45° FOV: 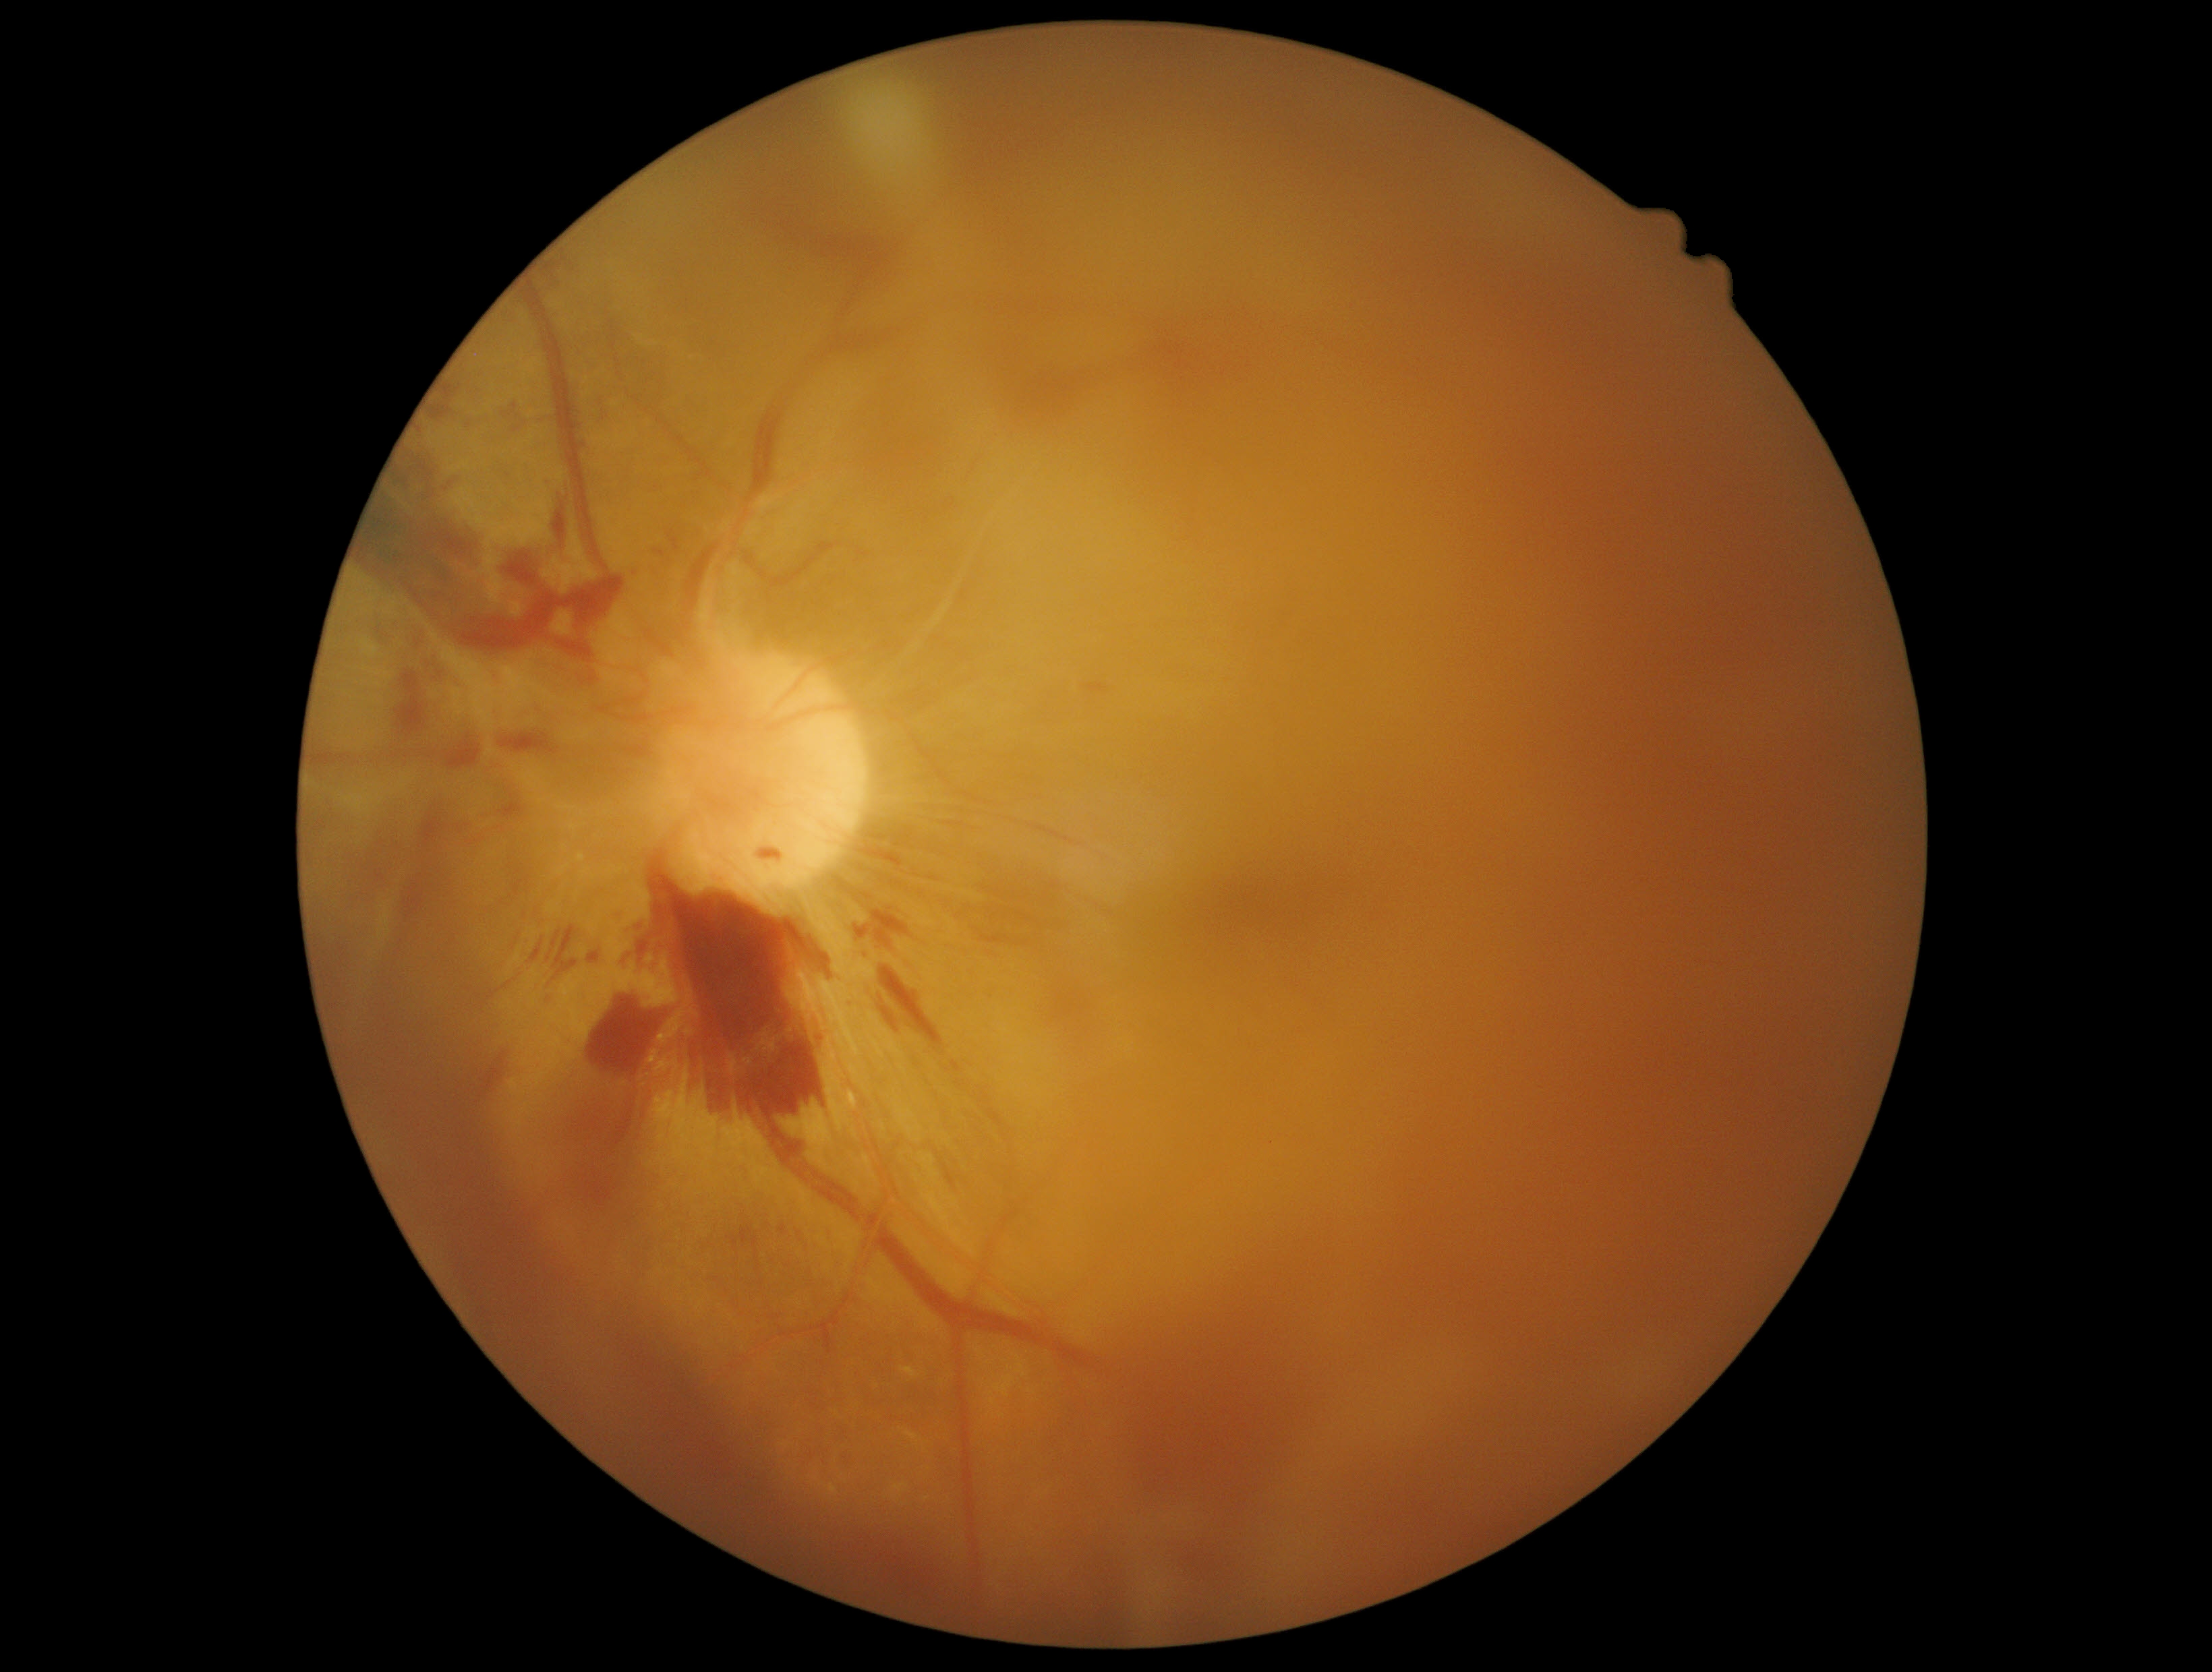
{"partial": true, "dr_grade": 4, "dr_grade_name": "PDR", "lesions": {"he": [[856, 822, 919, 873], [972, 874, 1066, 949], [377, 838, 385, 846], [933, 1148, 957, 1189], [1081, 678, 1111, 698], [465, 419, 473, 431], [640, 860, 834, 1136], [666, 529, 680, 555], [376, 626, 389, 640], [359, 861, 381, 872], [427, 381, 462, 423], [447, 733, 482, 769], [393, 669, 430, 745]], "he_small_approx": [[373, 855], [429, 665], [480, 376]]}}